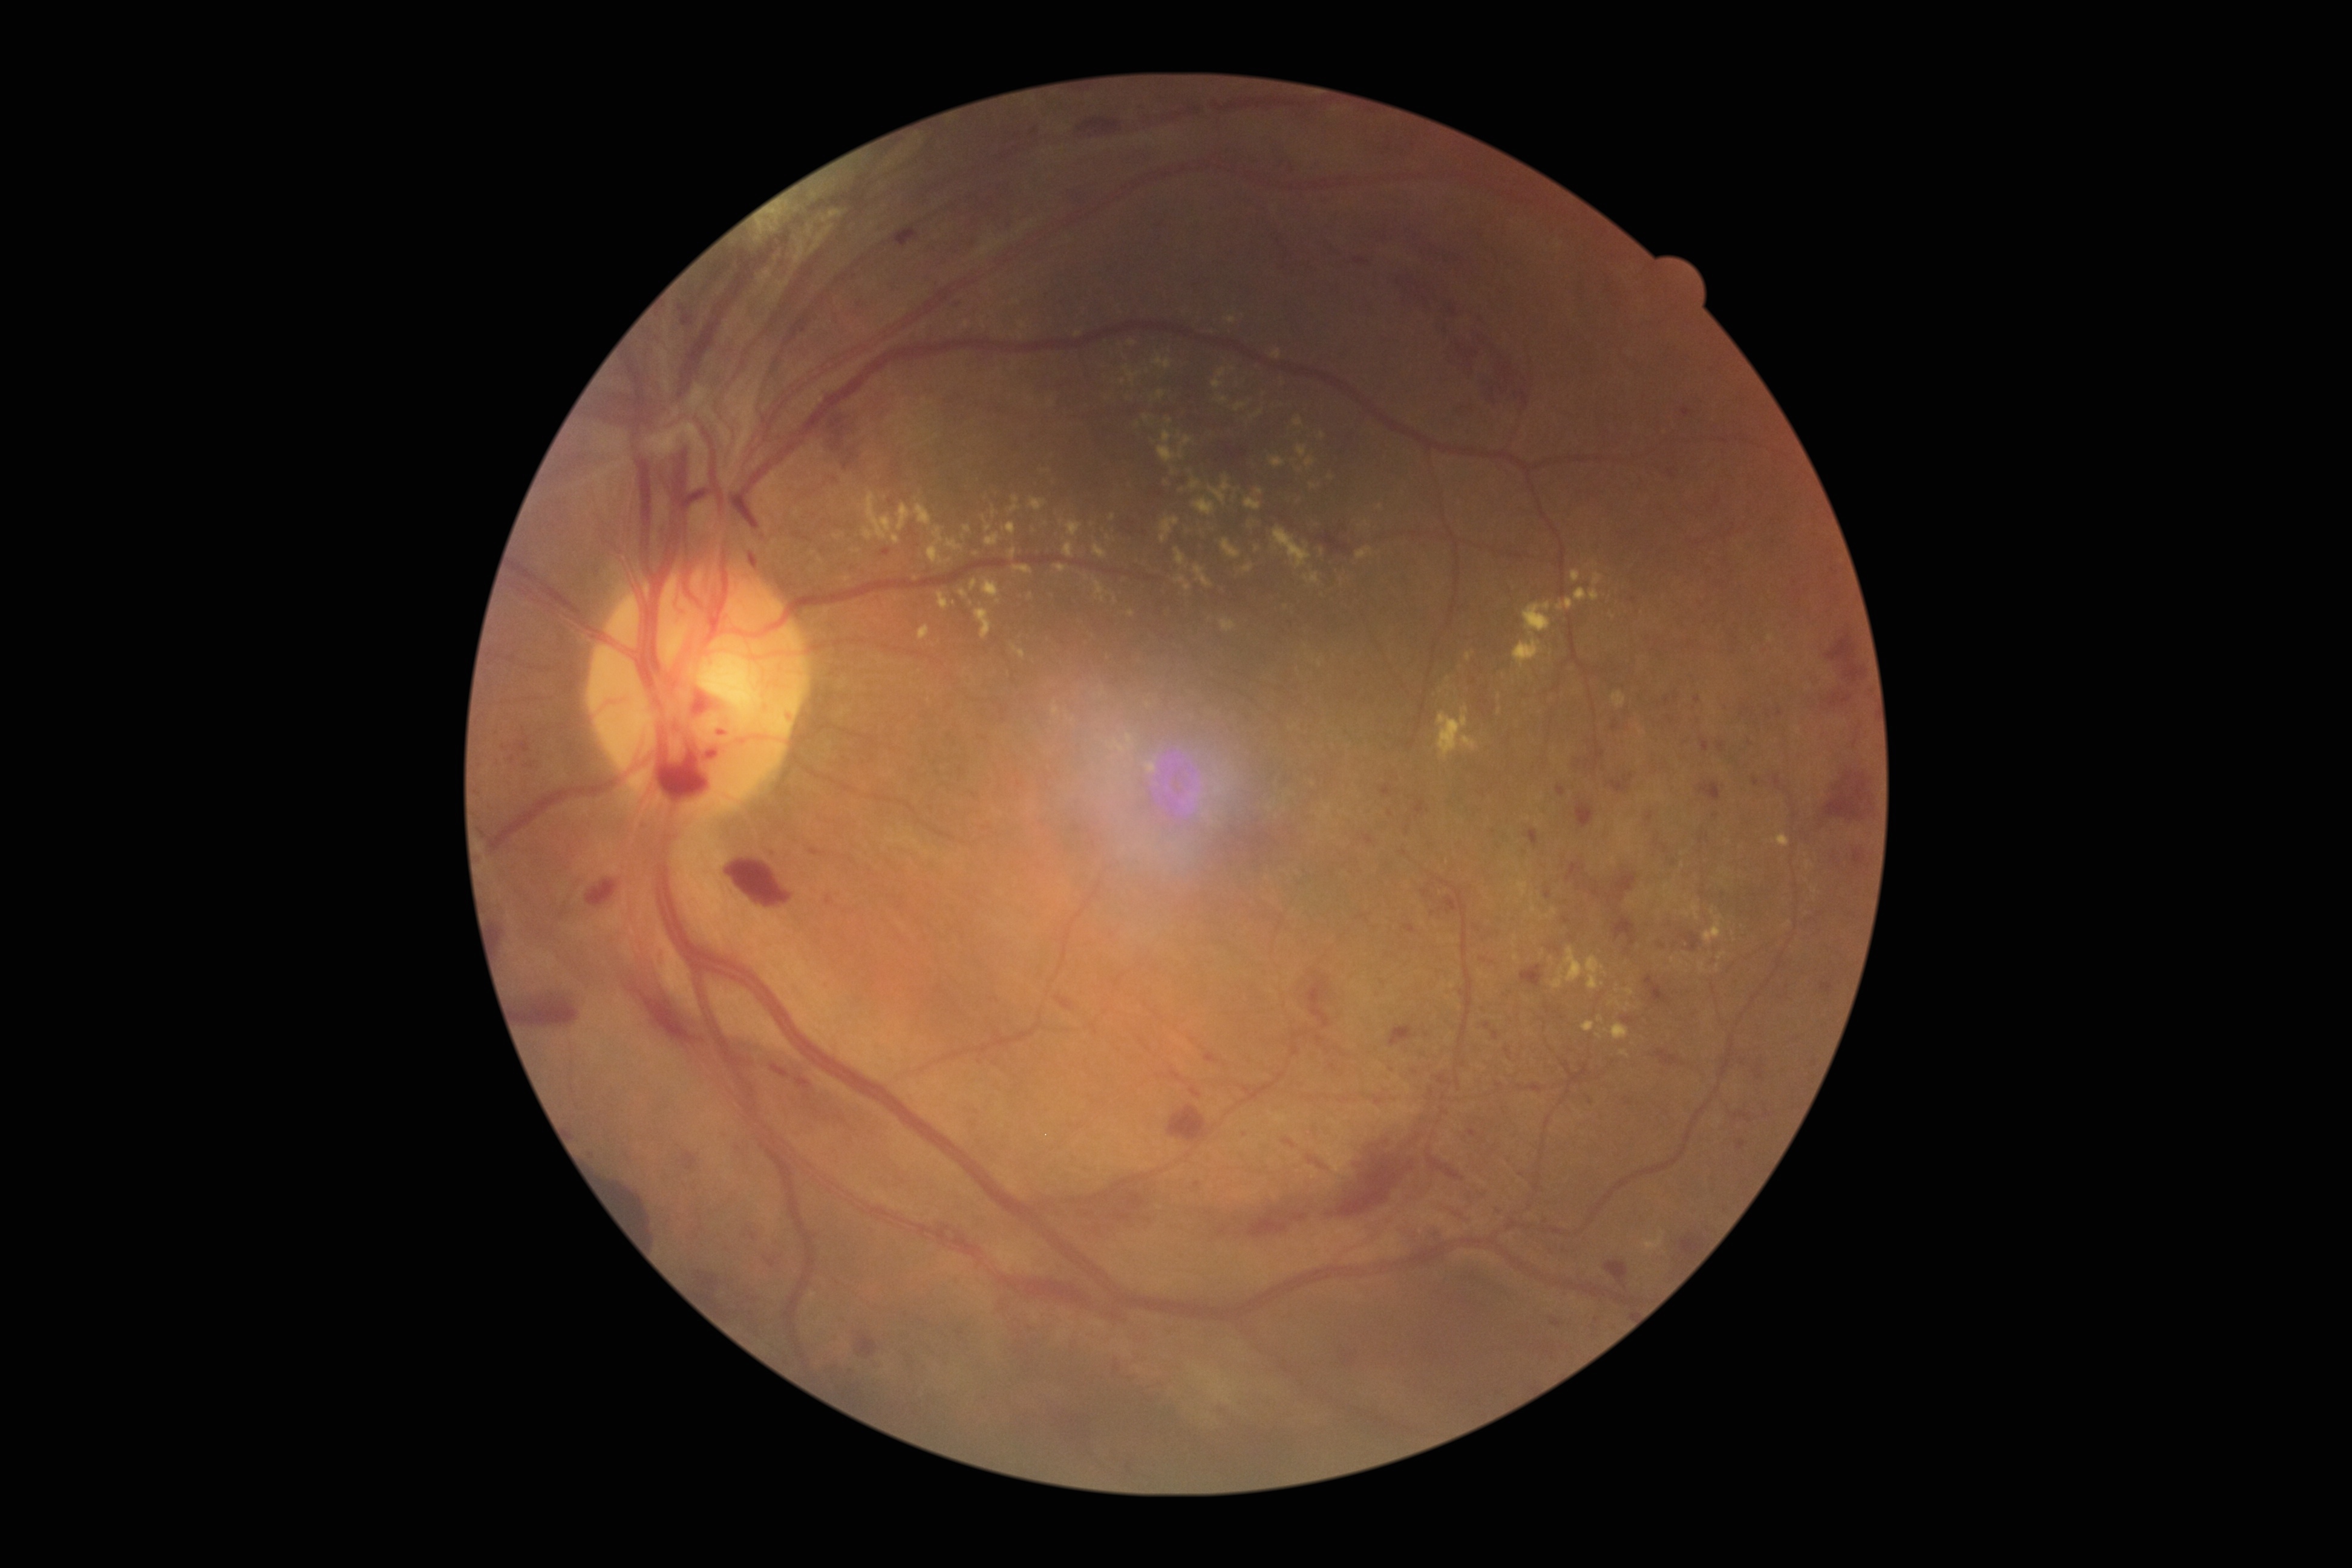

Diabetic retinopathy severity: grade 4.